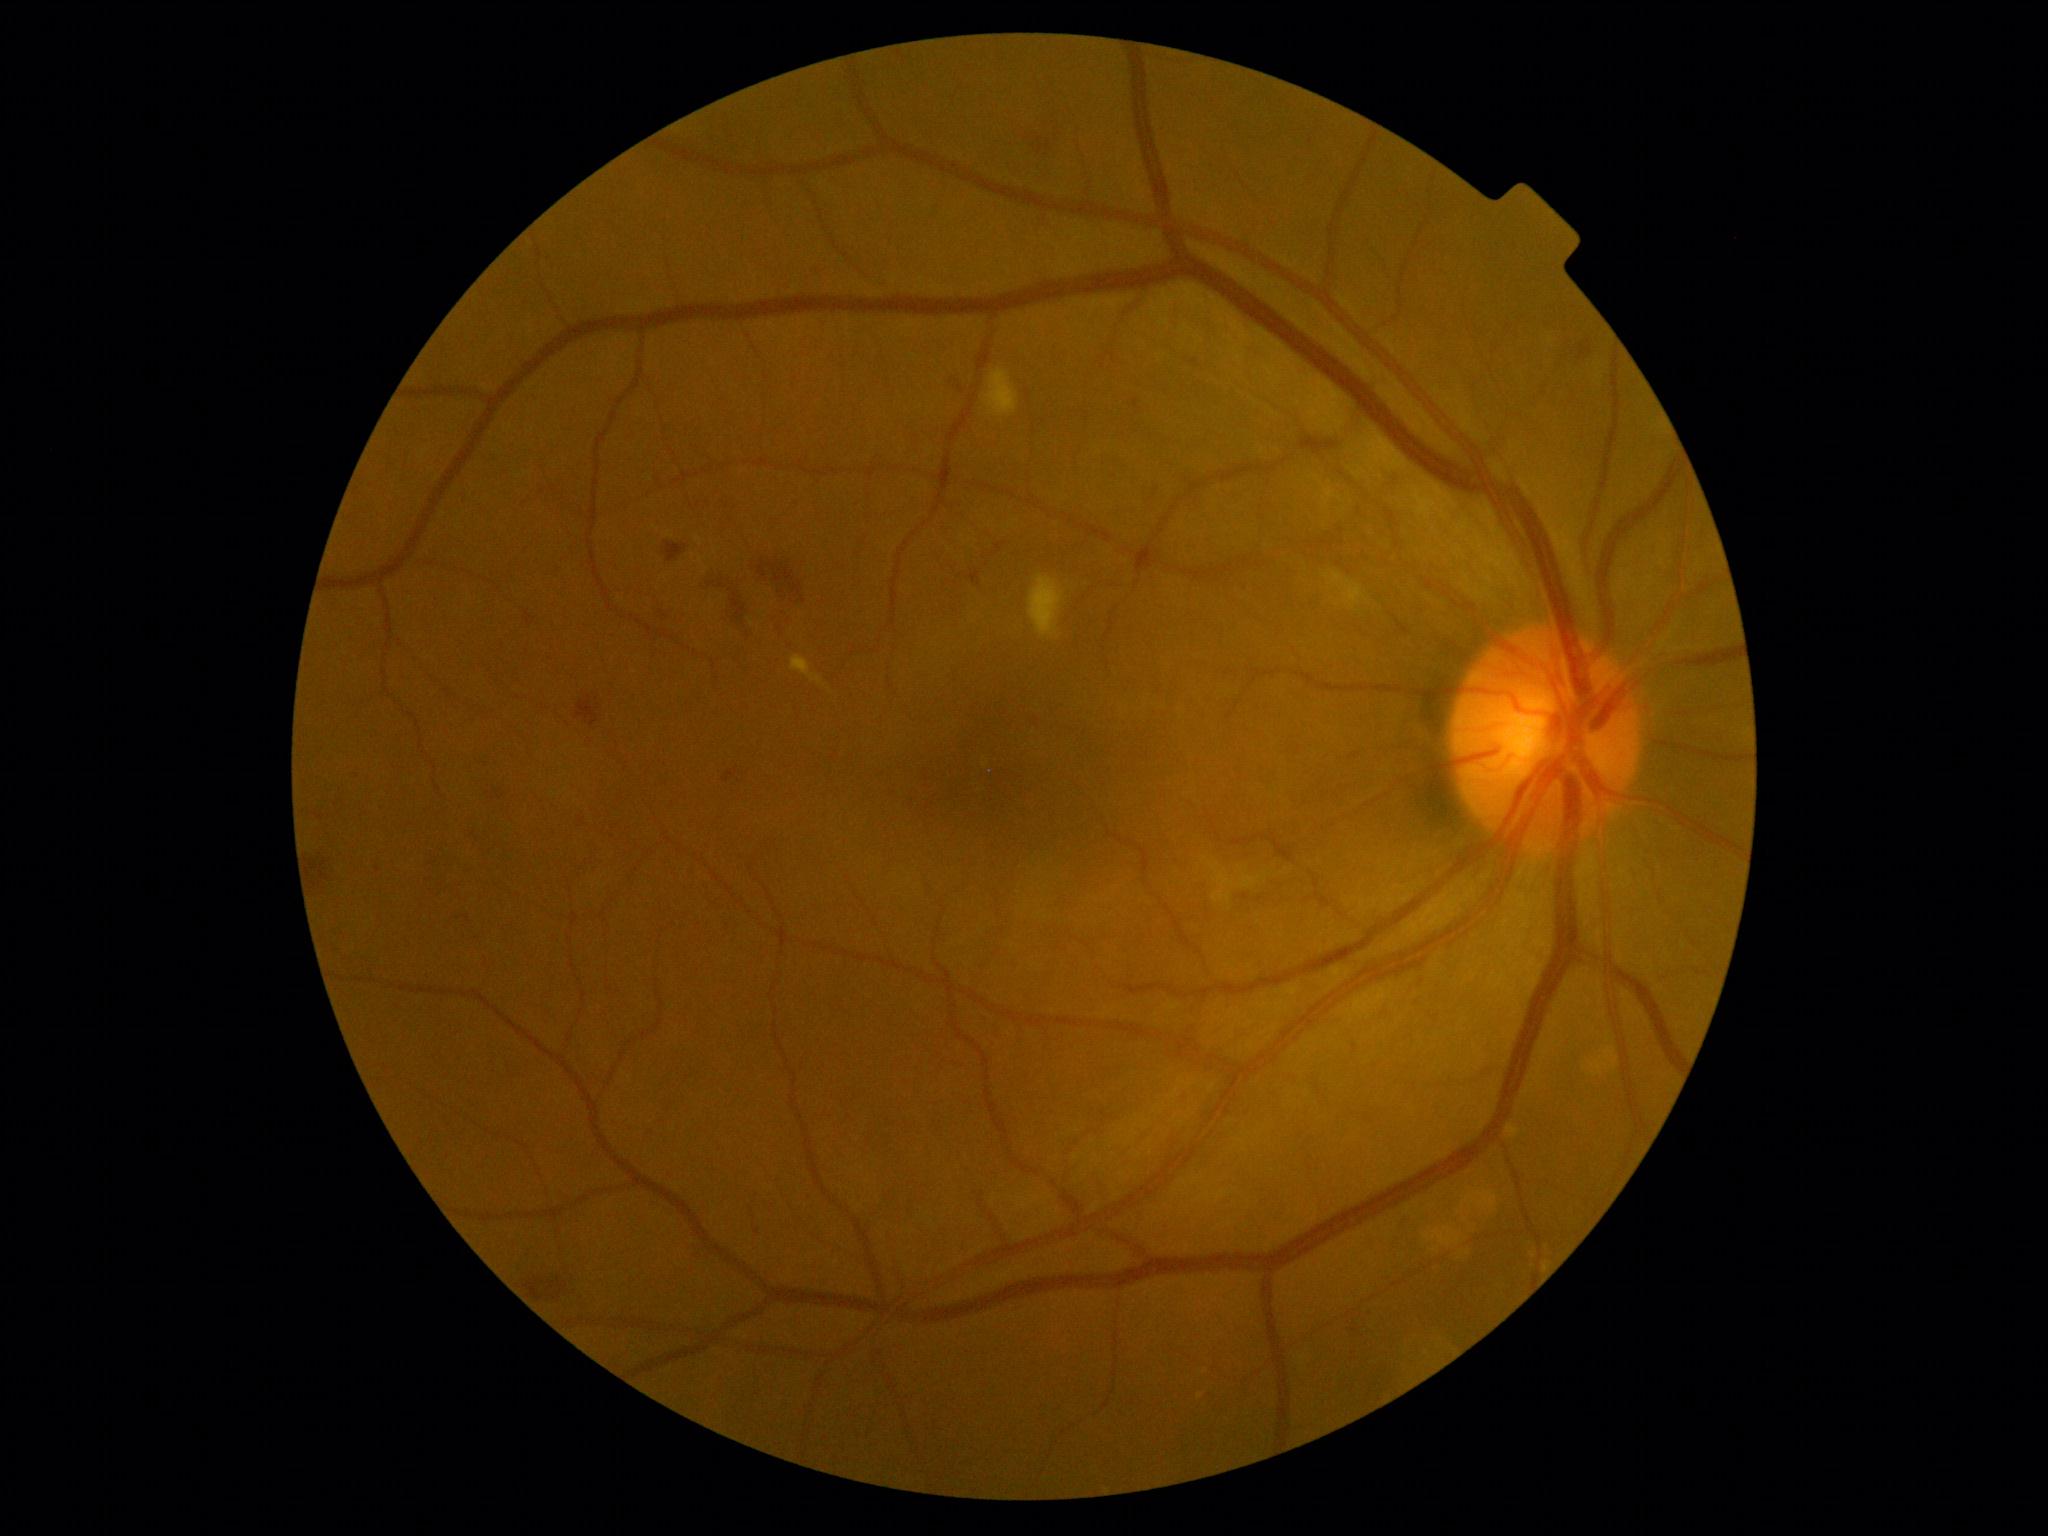 DR class = non-proliferative diabetic retinopathy
DR severity = 2